45° FOV
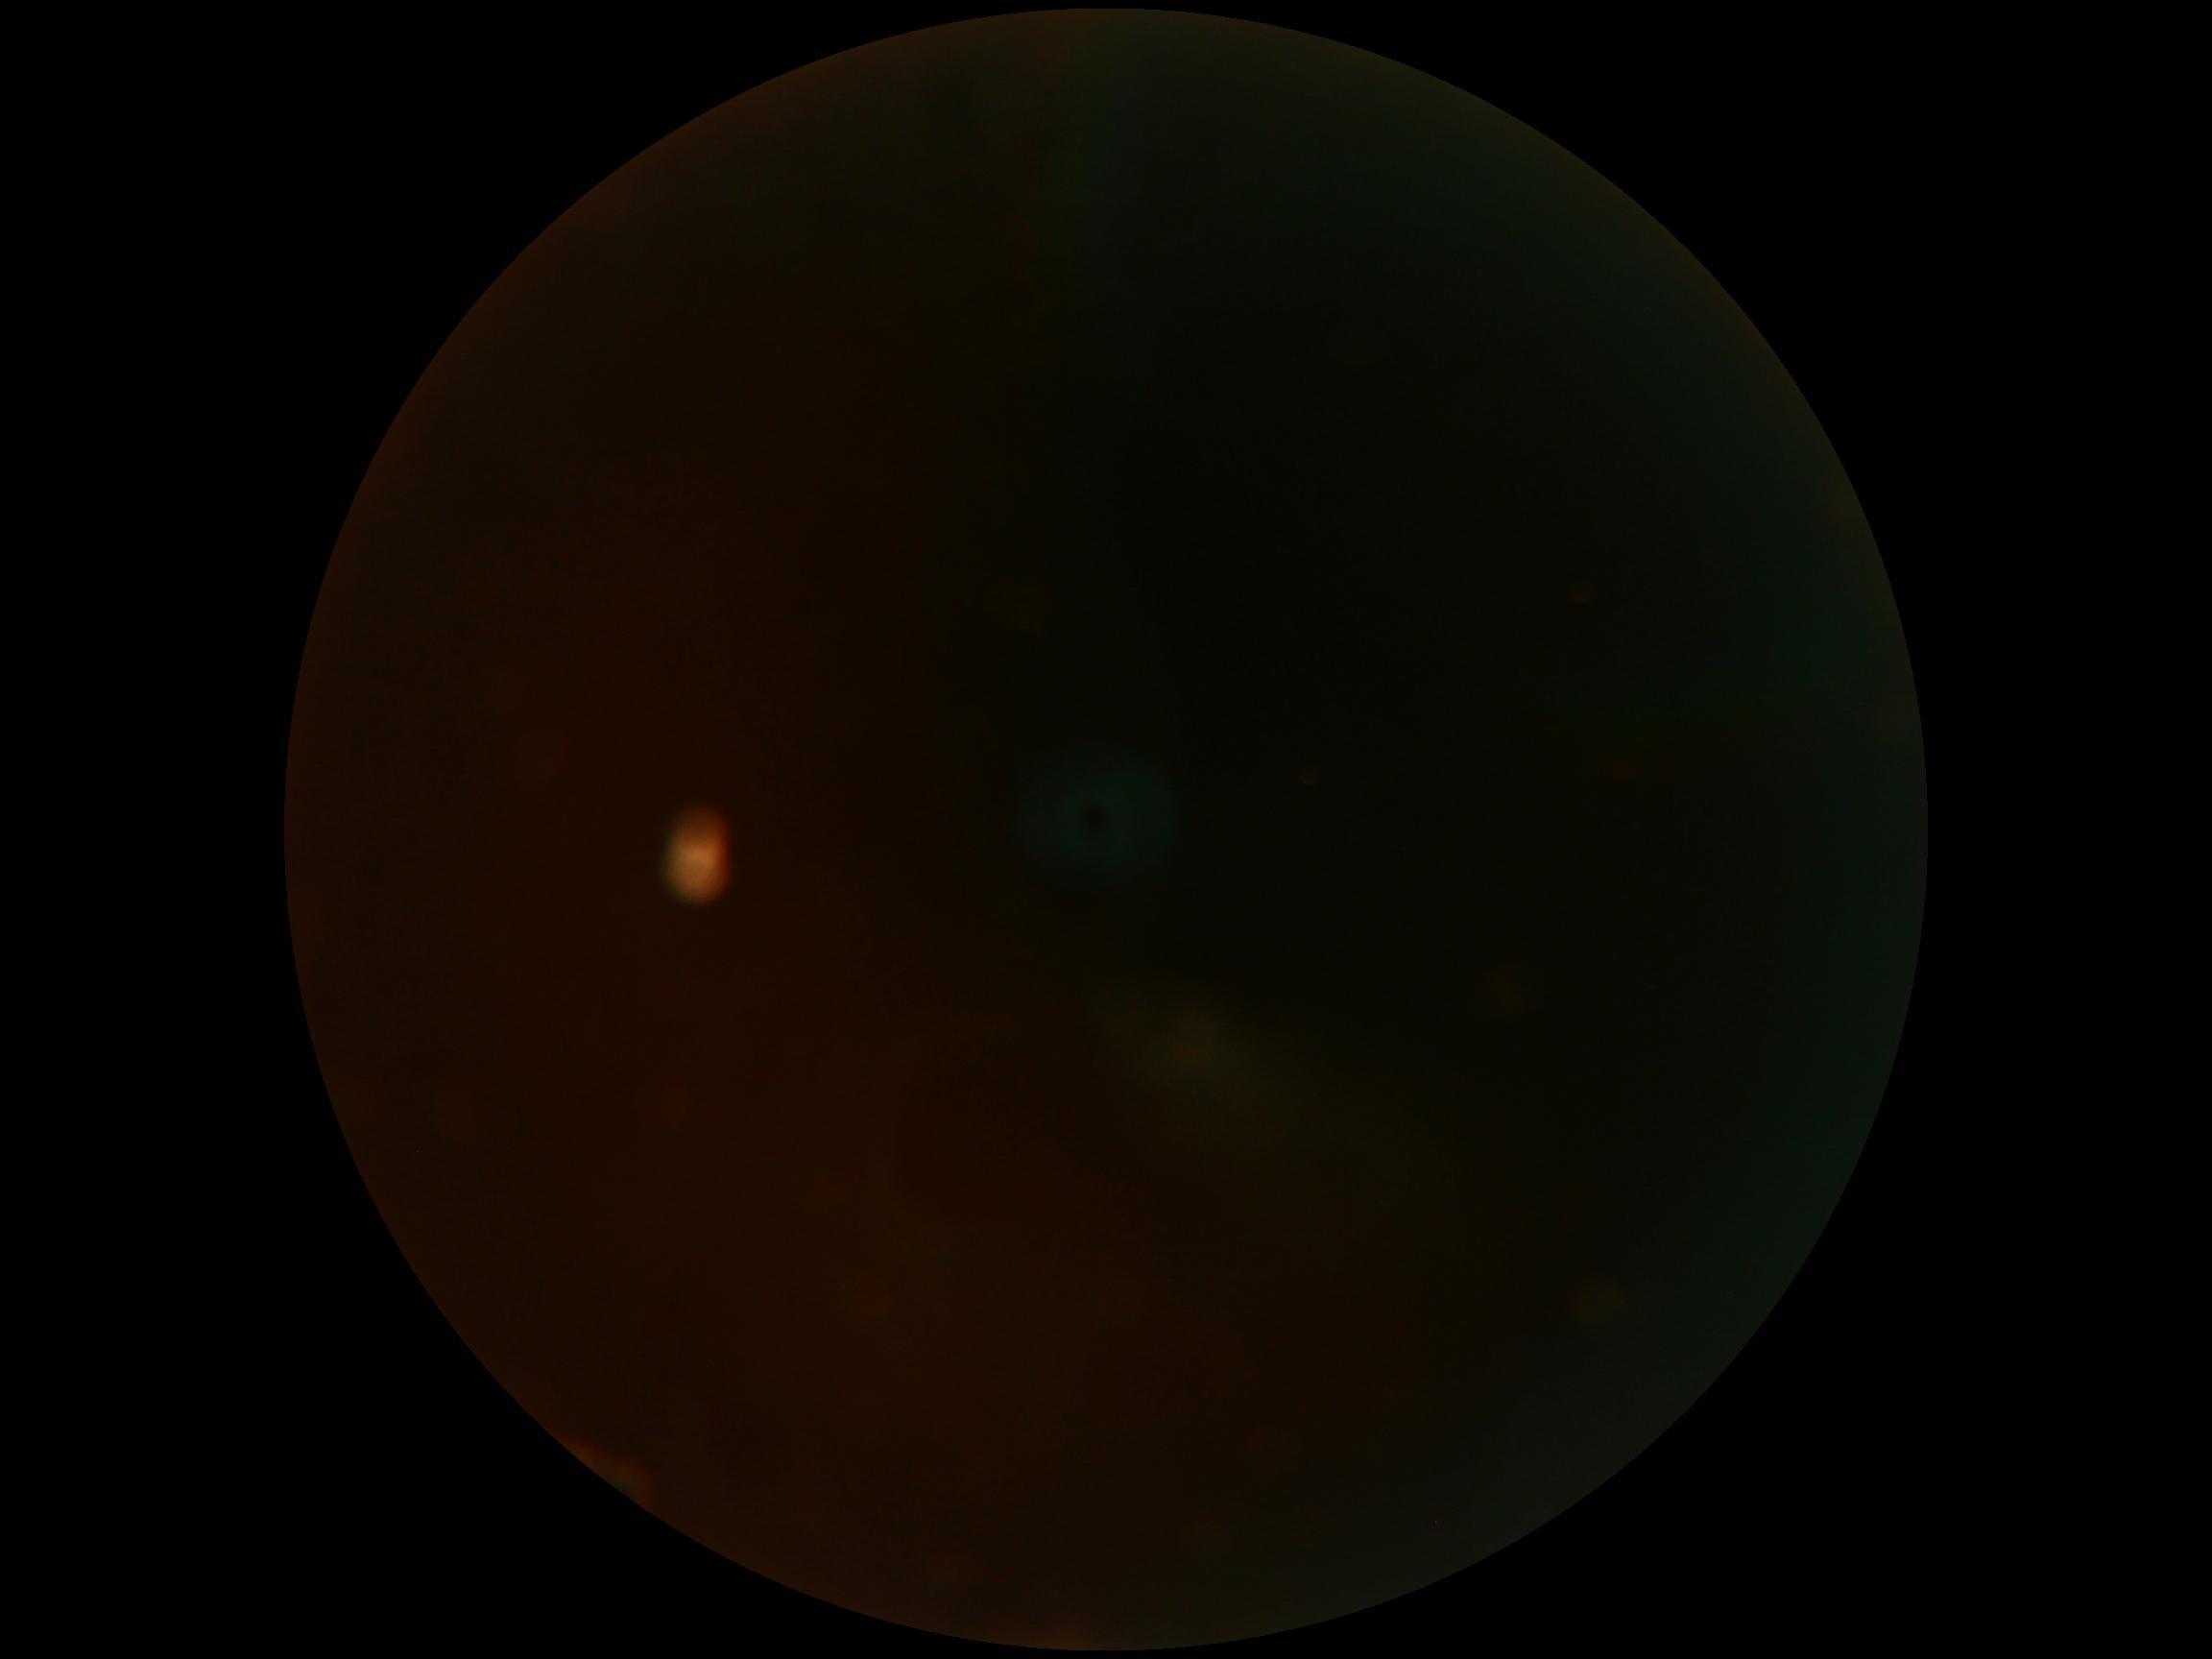
image quality: insufficient for DR assessment; DR stage: ungradable.